Color fundus photograph: 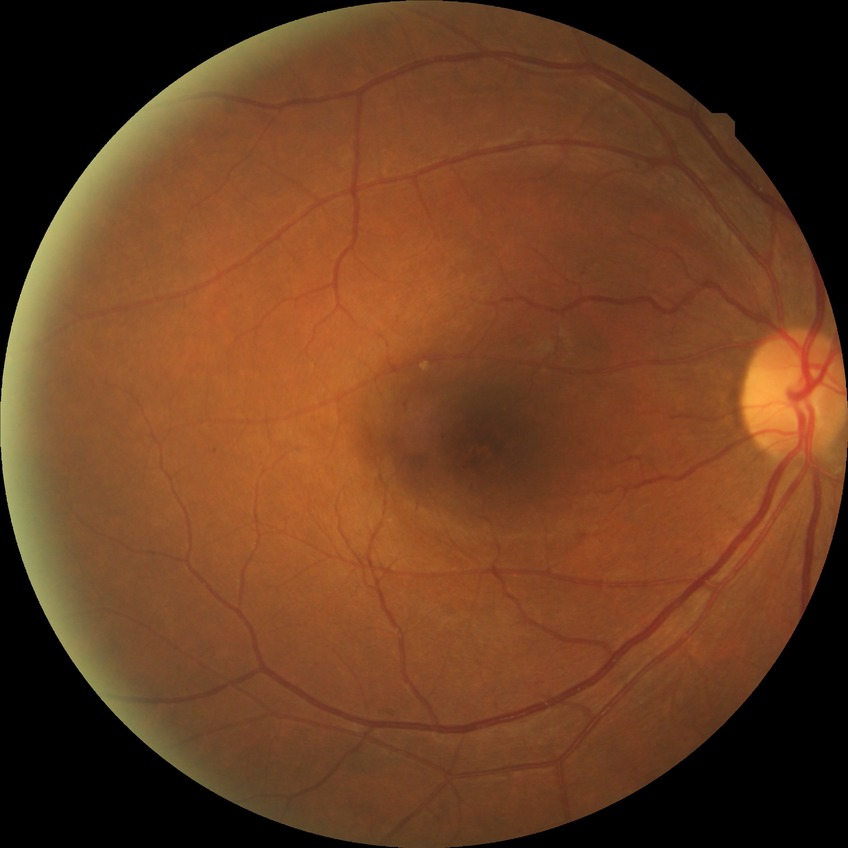 {
  "davis_grade": "no diabetic retinopathy (NDR)"
}